Fundus photo.
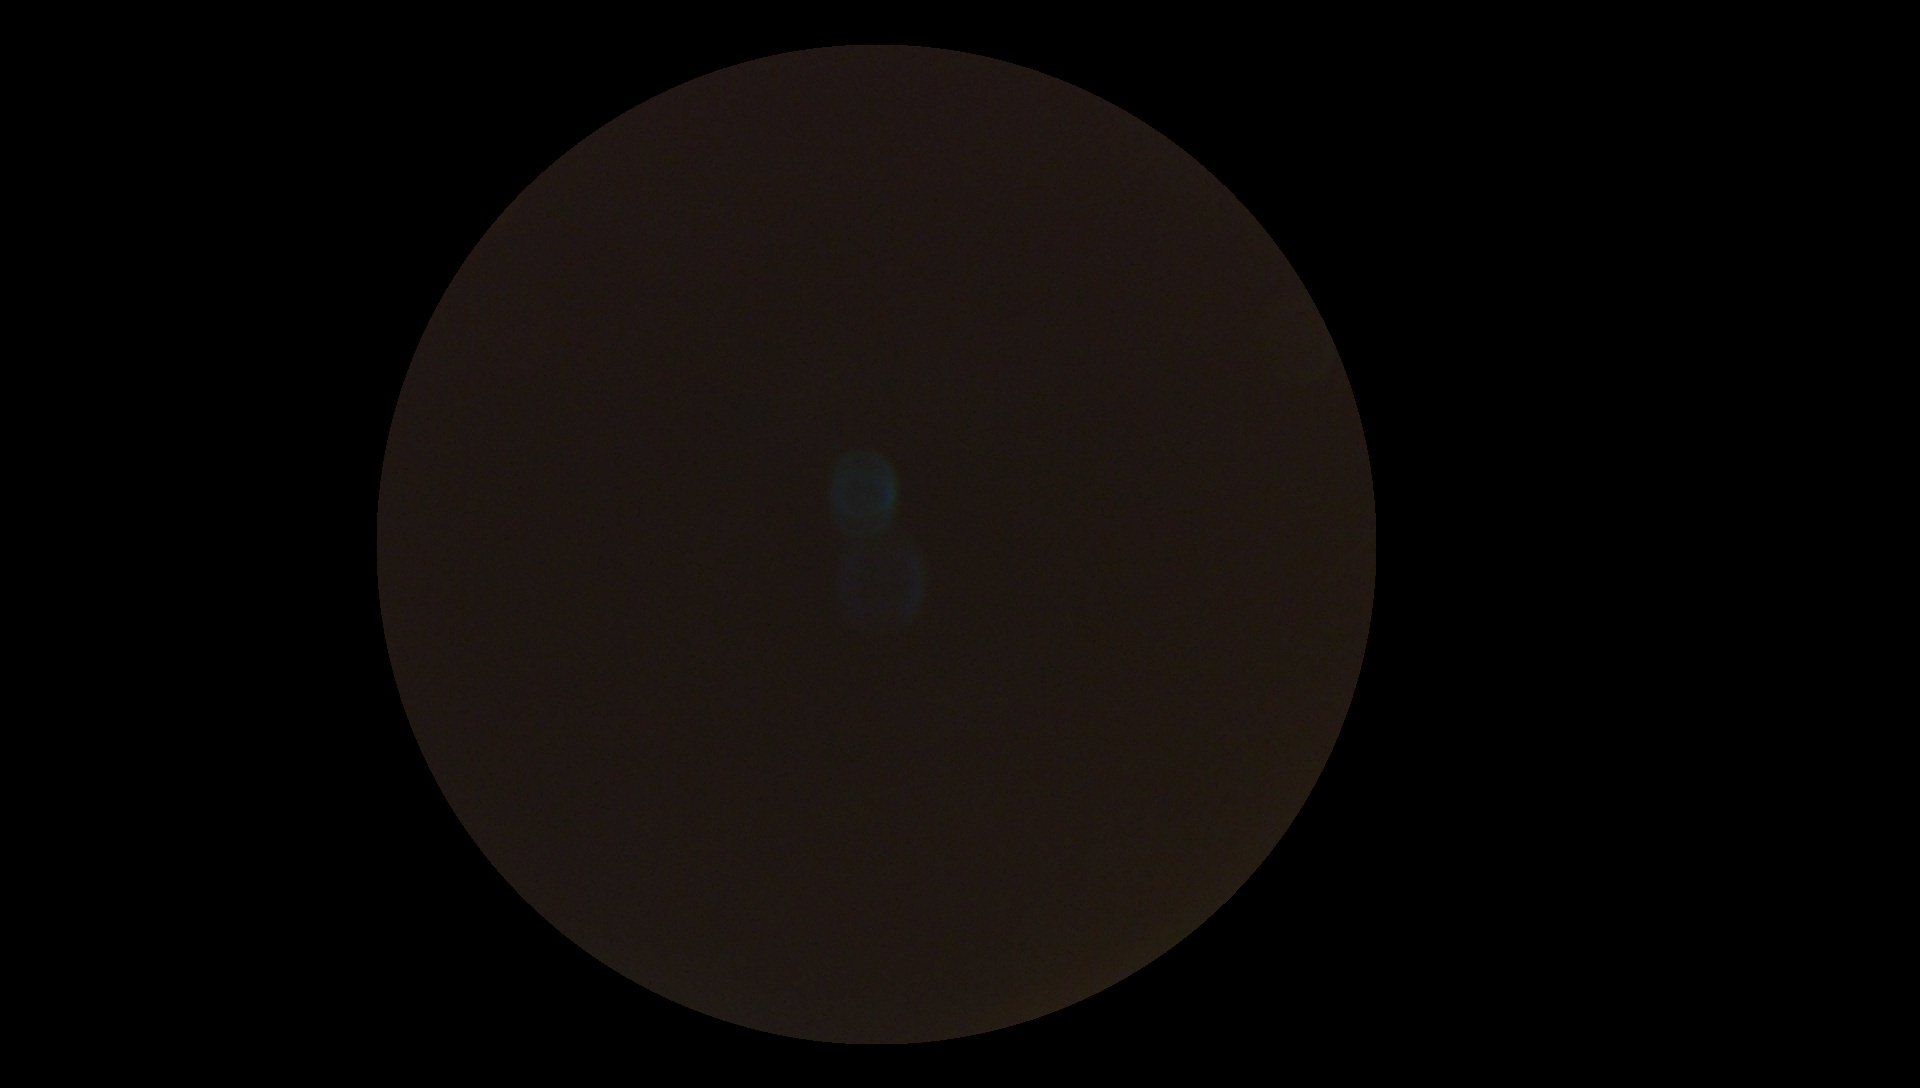 Diabetic retinopathy is ungradable.
Image quality is insufficient for diabetic retinopathy assessment.